848 by 848 pixels.
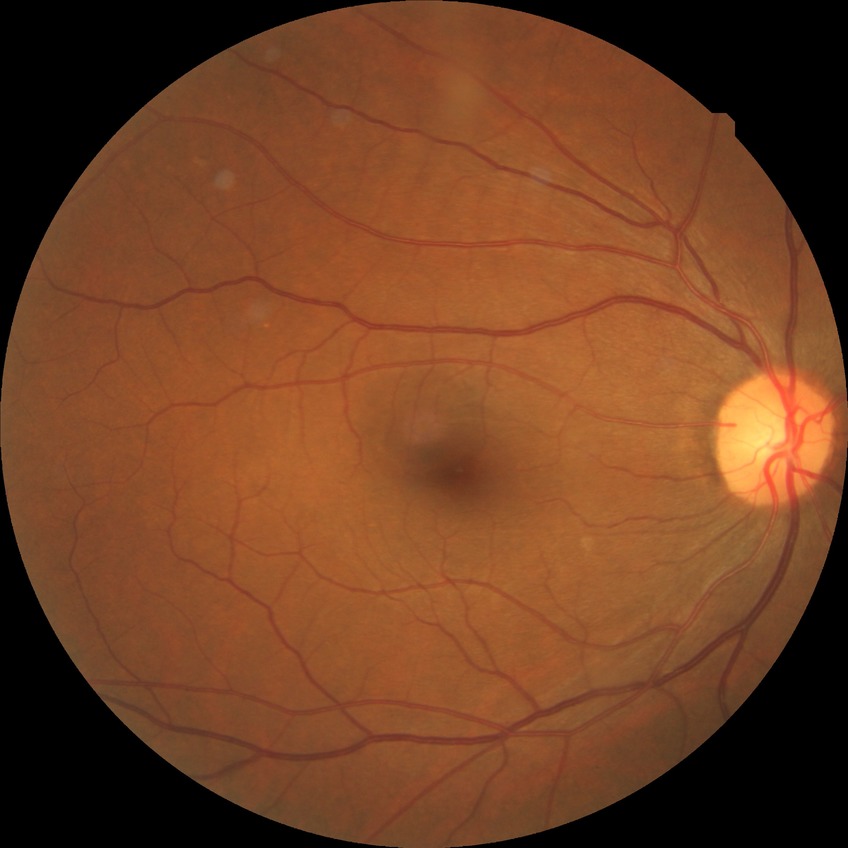

  davis_grade: no diabetic retinopathy (NDR)